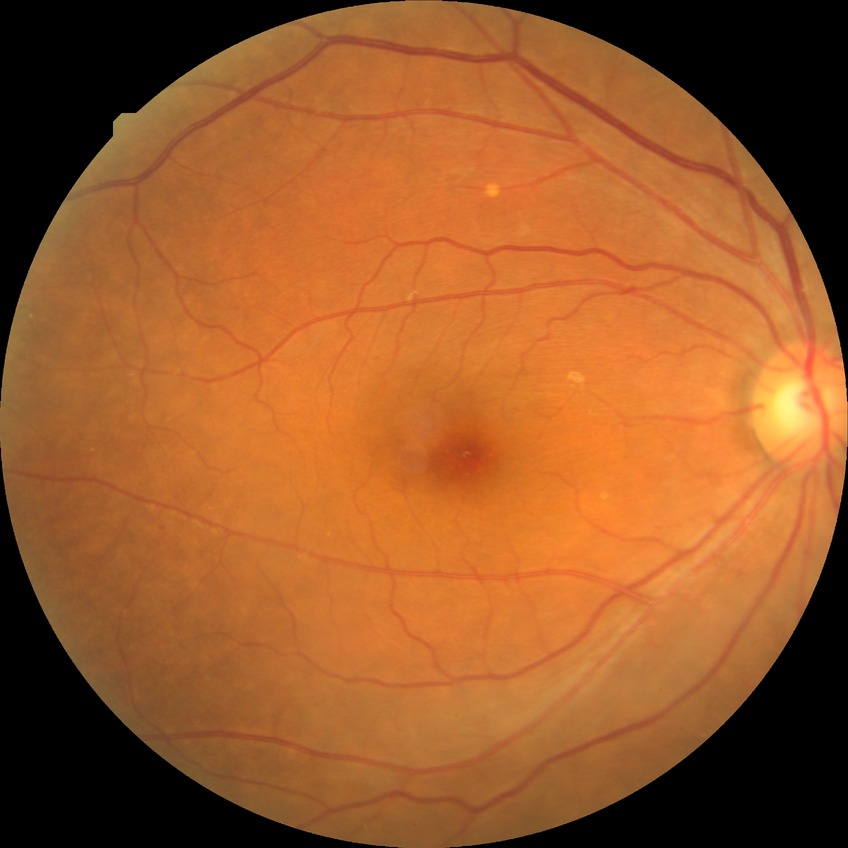

Annotations:
- diabetic retinopathy stage: simple diabetic retinopathy